Color fundus photograph
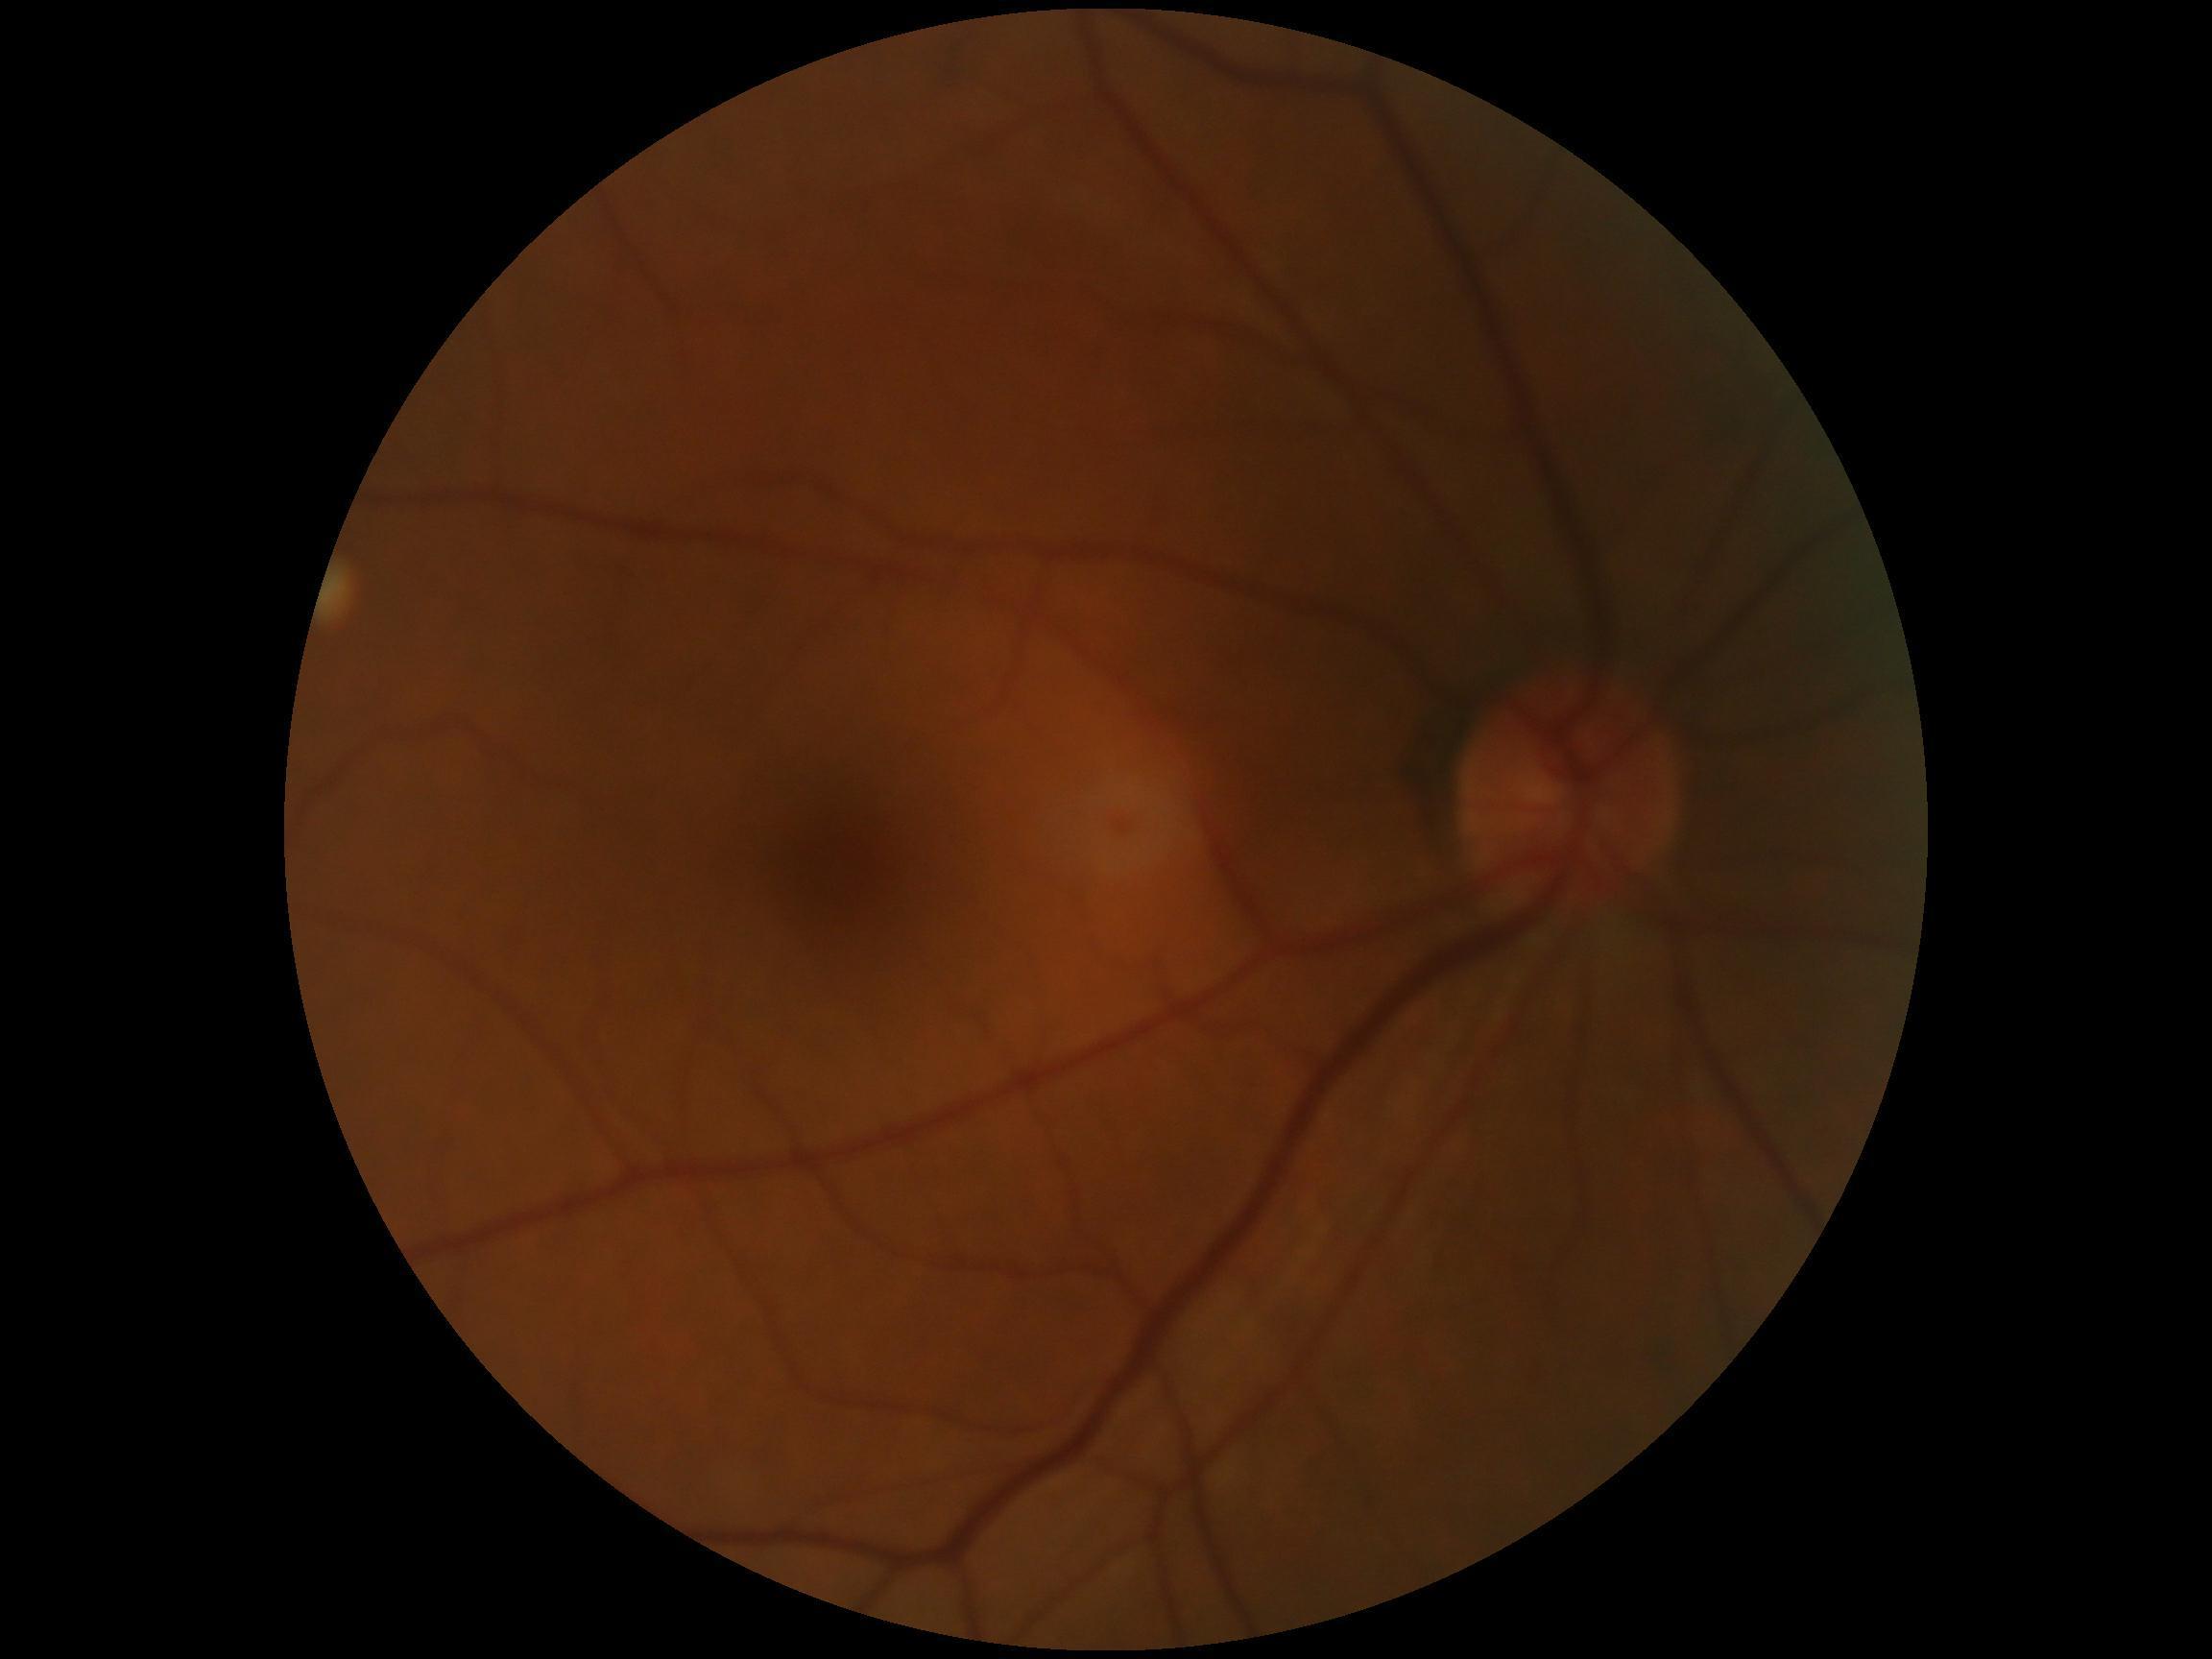

Retinopathy grade is 0 (no apparent retinopathy).